Modified Davis grading.
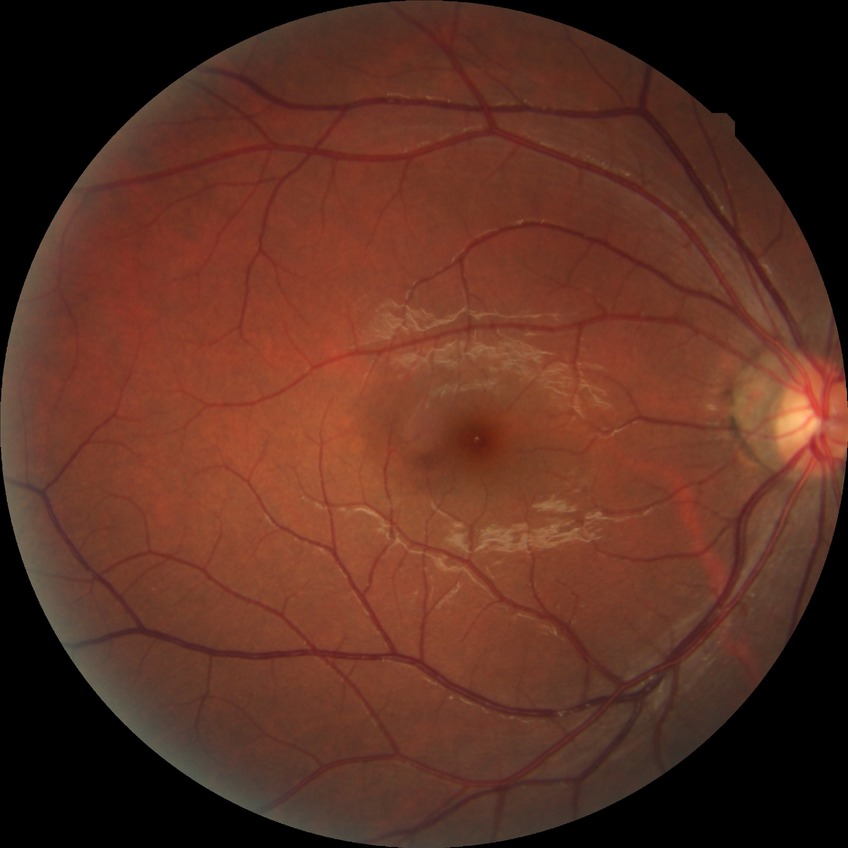 Modified Davis grade: NDR. No diabetic retinal disease findings.